Wide-field fundus photograph from neonatal ROP screening; 130° field of view (Clarity RetCam 3) — 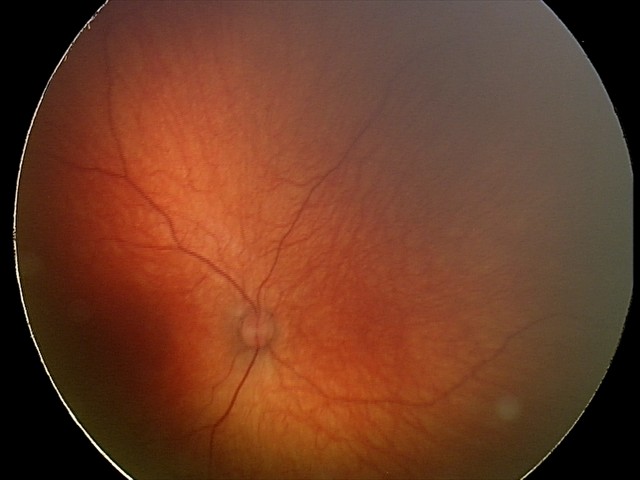

Impression = no abnormalities.